Retinal fundus photograph: 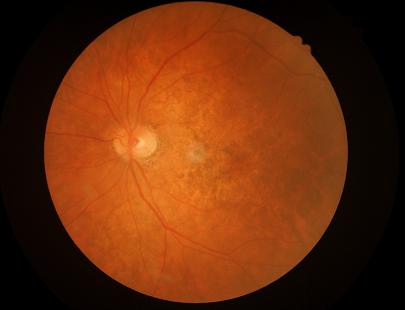

Overall quality is good and the image is gradable.
Illumination is even.
Adequate contrast for distinguishing structures.
Image is sharp throughout the field.